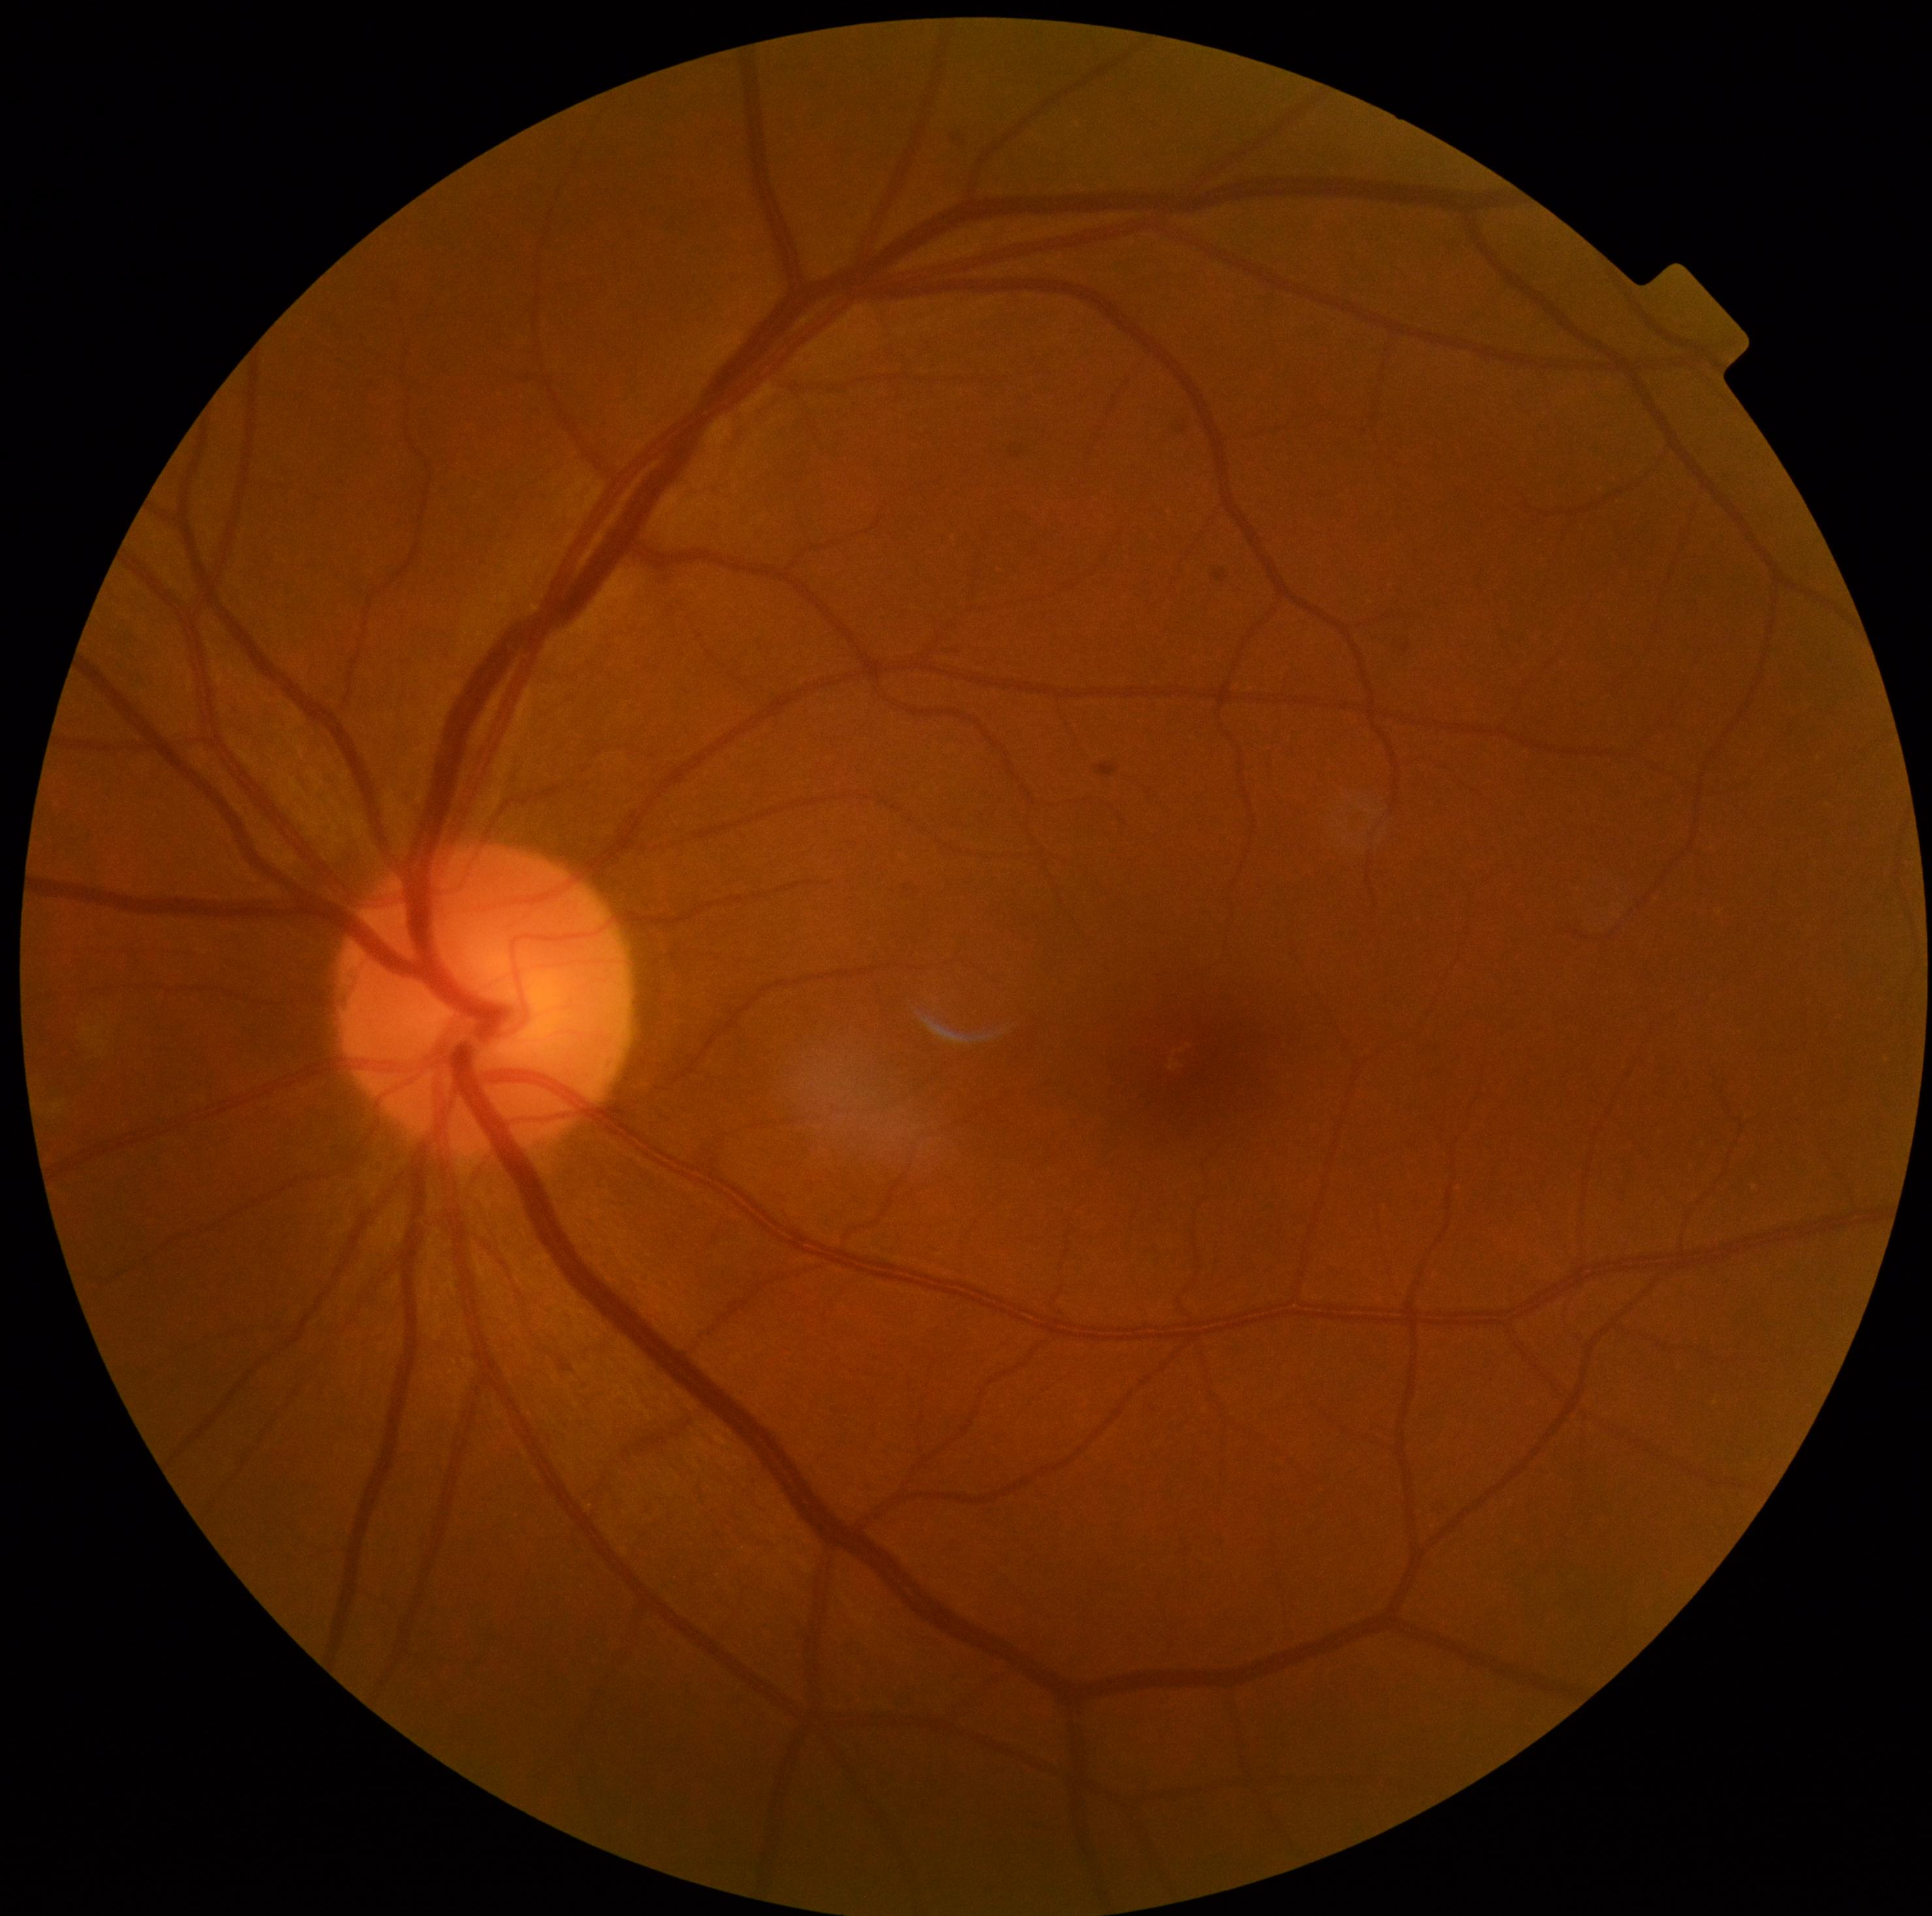
No apparent diabetic retinopathy.
Diabetic retinopathy (DR) is grade 0 (no apparent retinopathy).